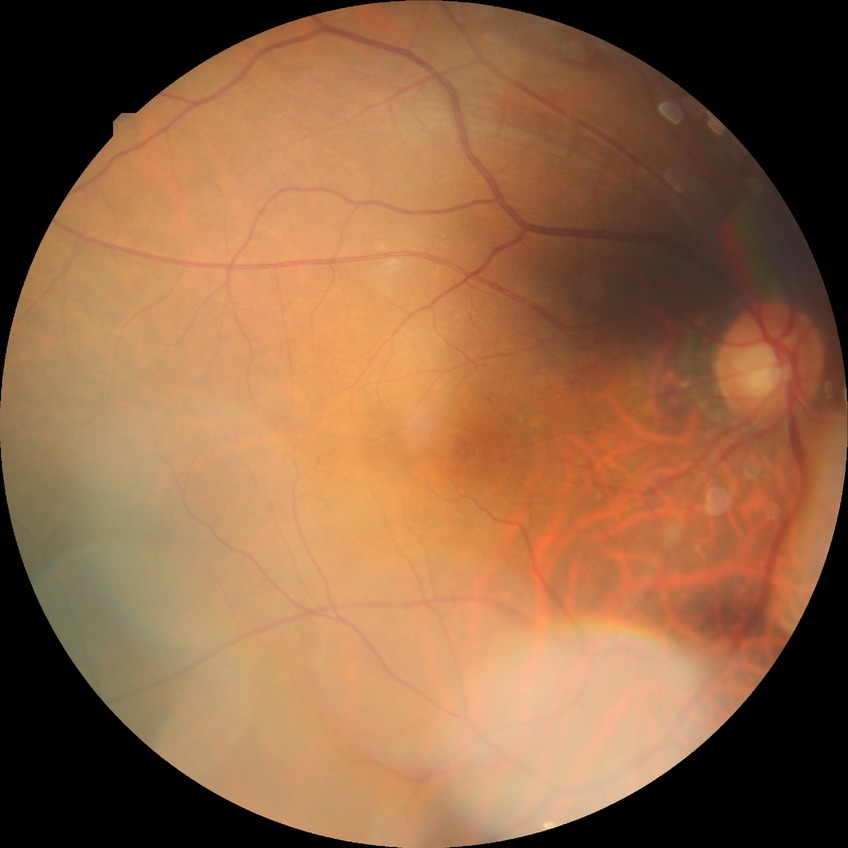

davis_grade: simple diabetic retinopathy